2212 by 1659 pixels — 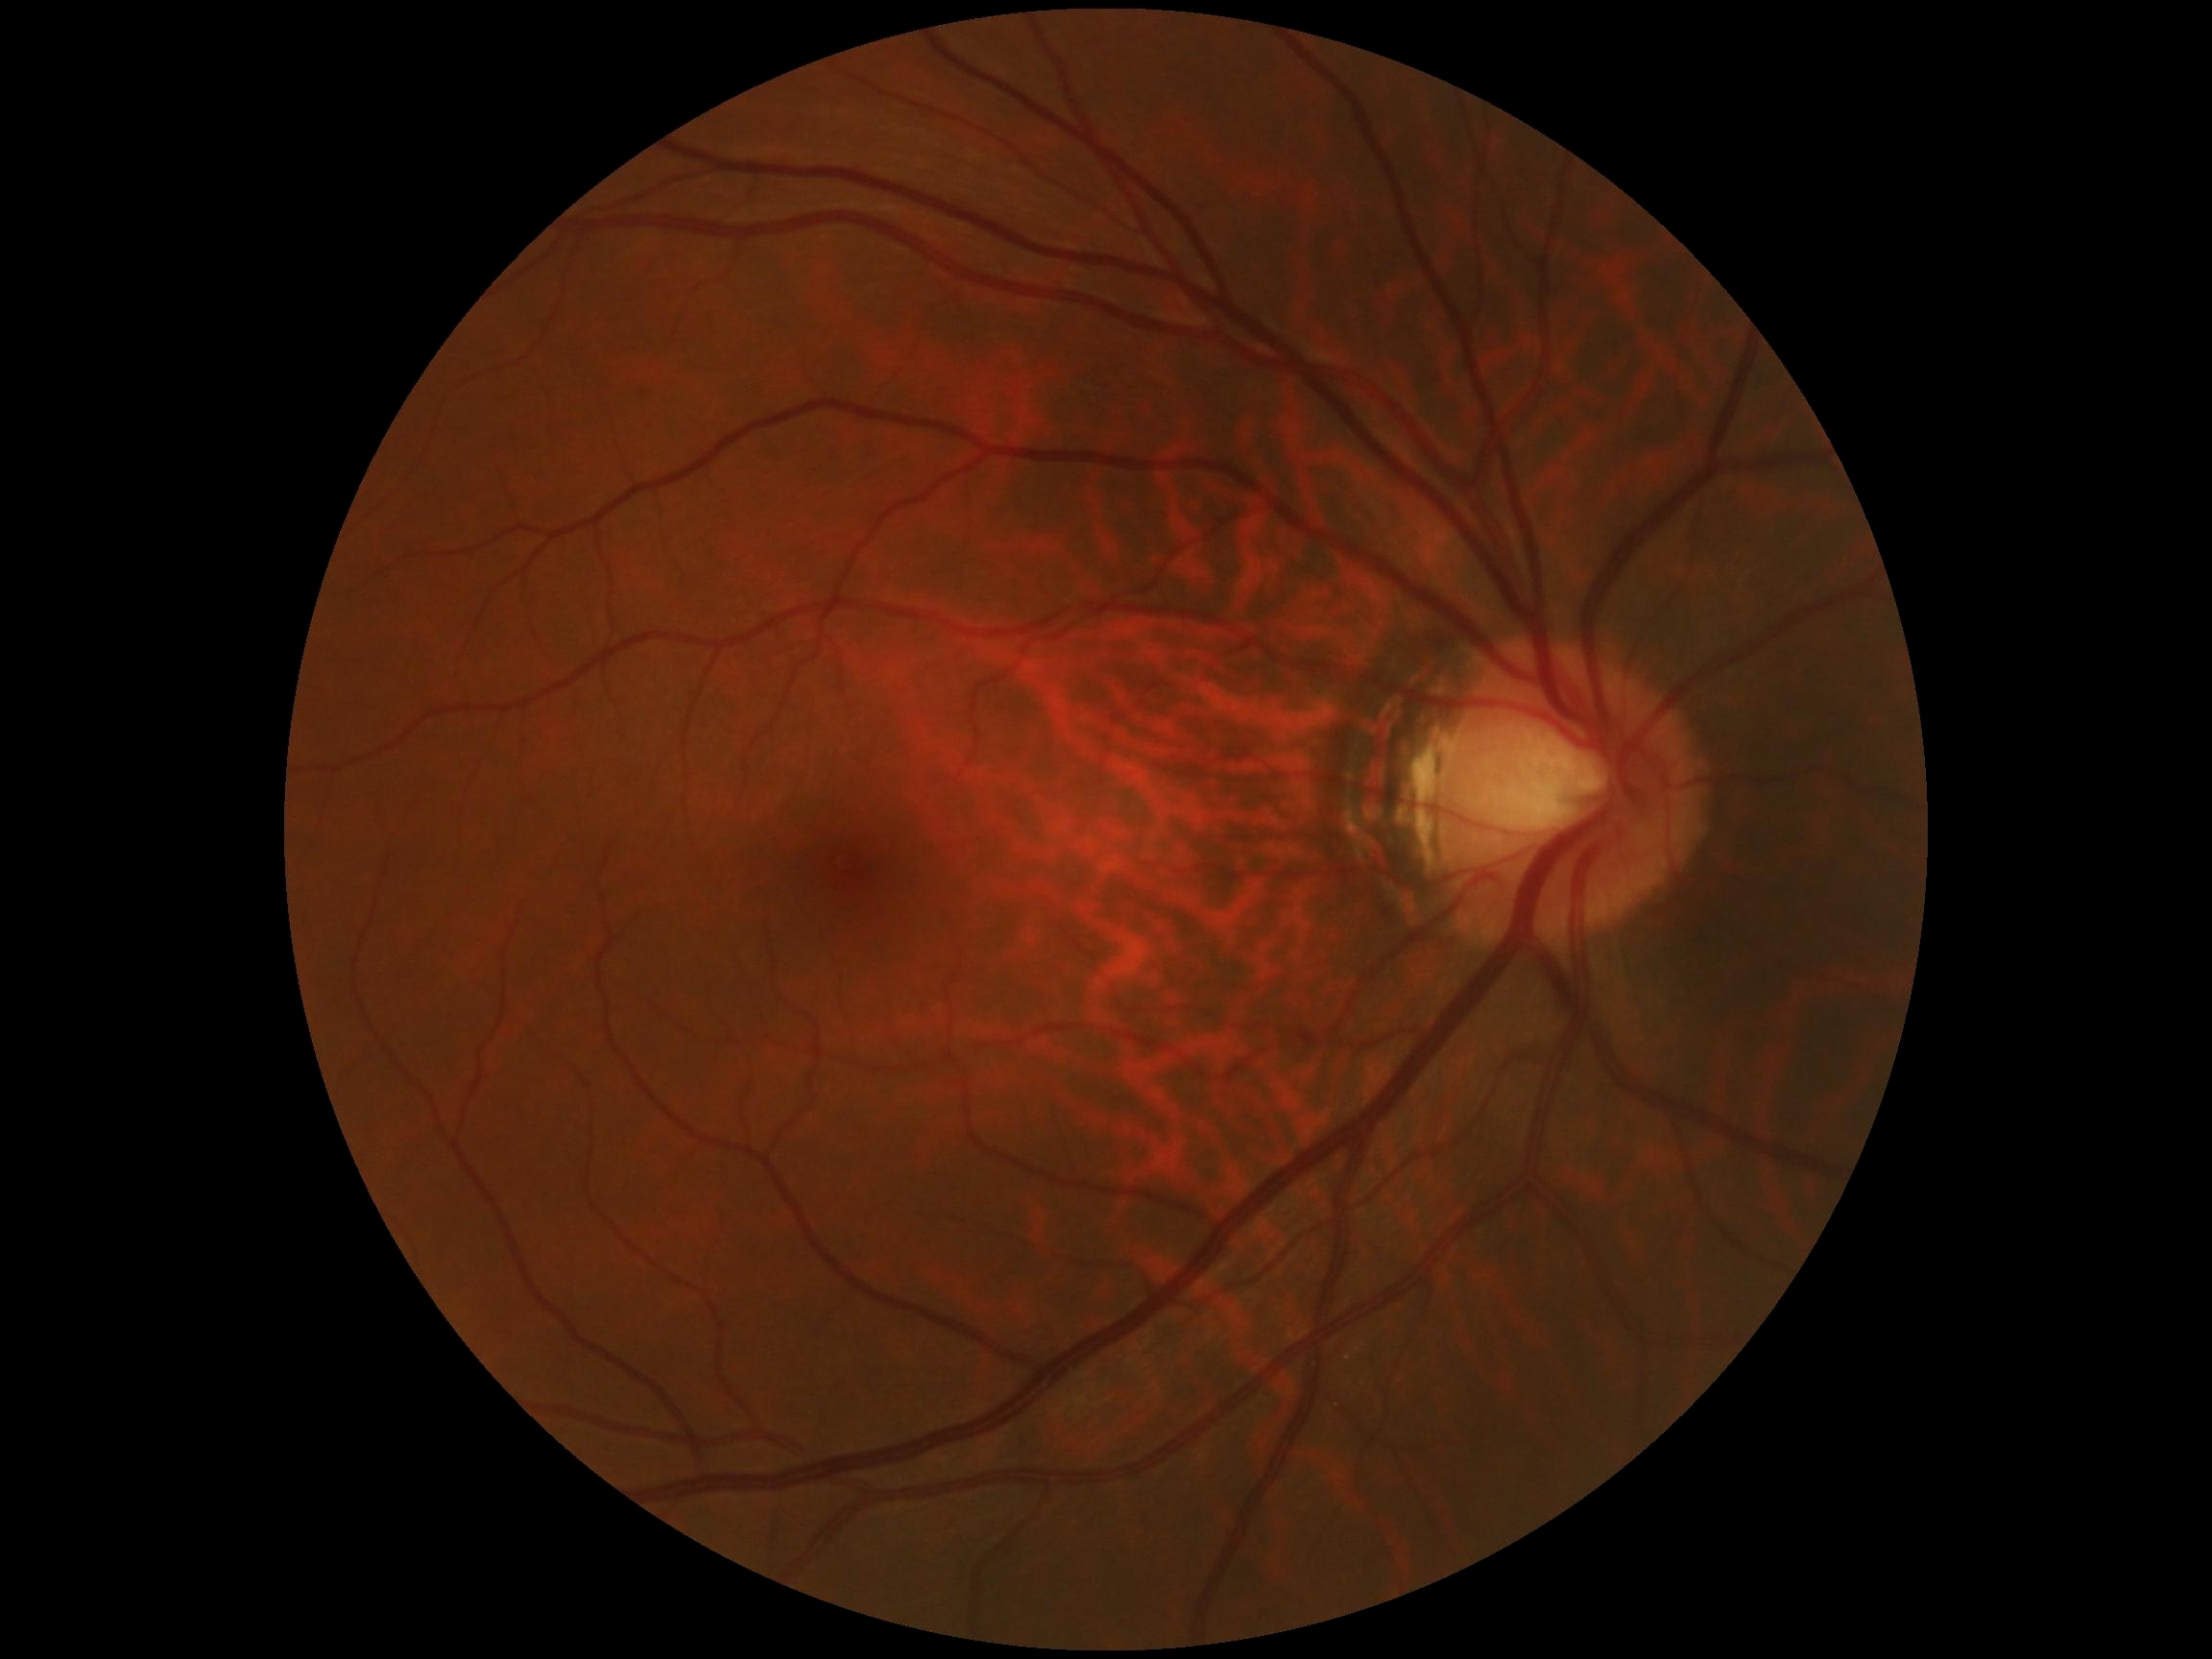 Annotations:
• DR impression: no DR findings
• DR: grade 0 (no apparent retinopathy)